Wide-field contact fundus photograph of an infant.
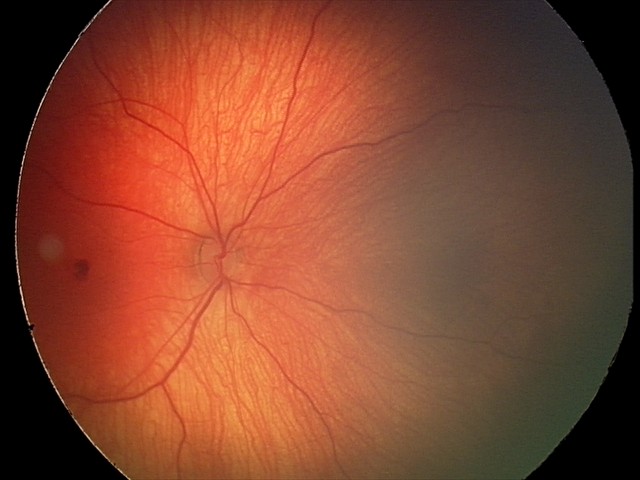 Impression: retinal hemorrhages.